NIDEK AFC-230 fundus camera: 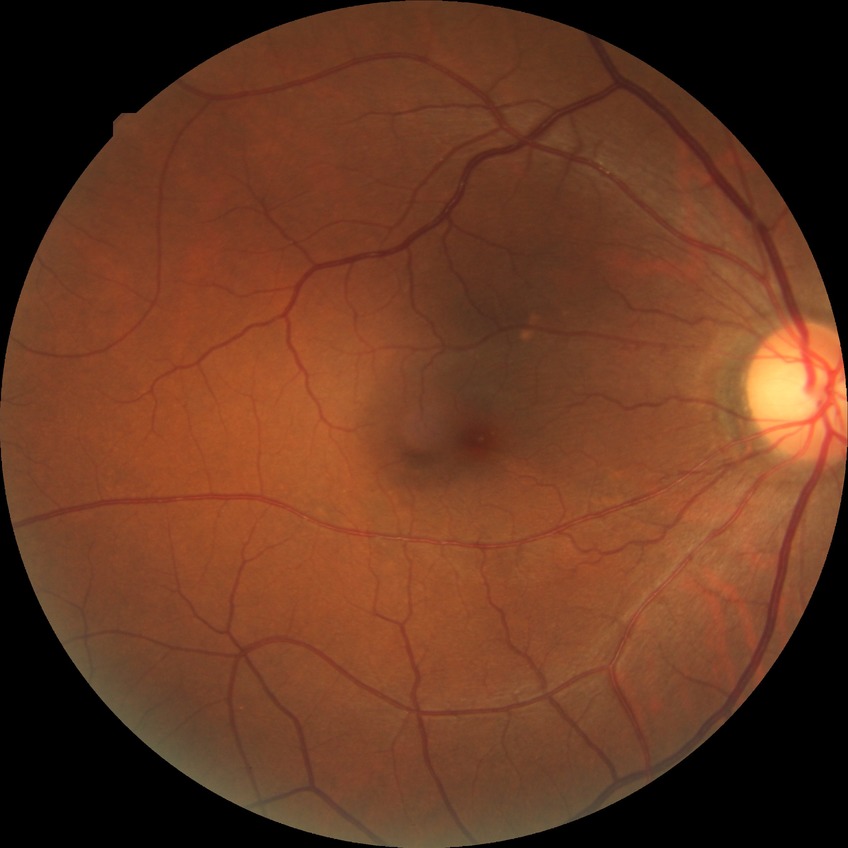

diabetic retinopathy stage@simple diabetic retinopathy.